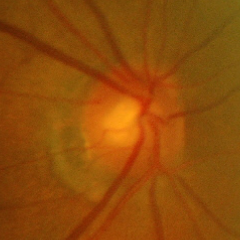 Glaucoma is present. Glaucoma assessment: early-stage glaucoma.